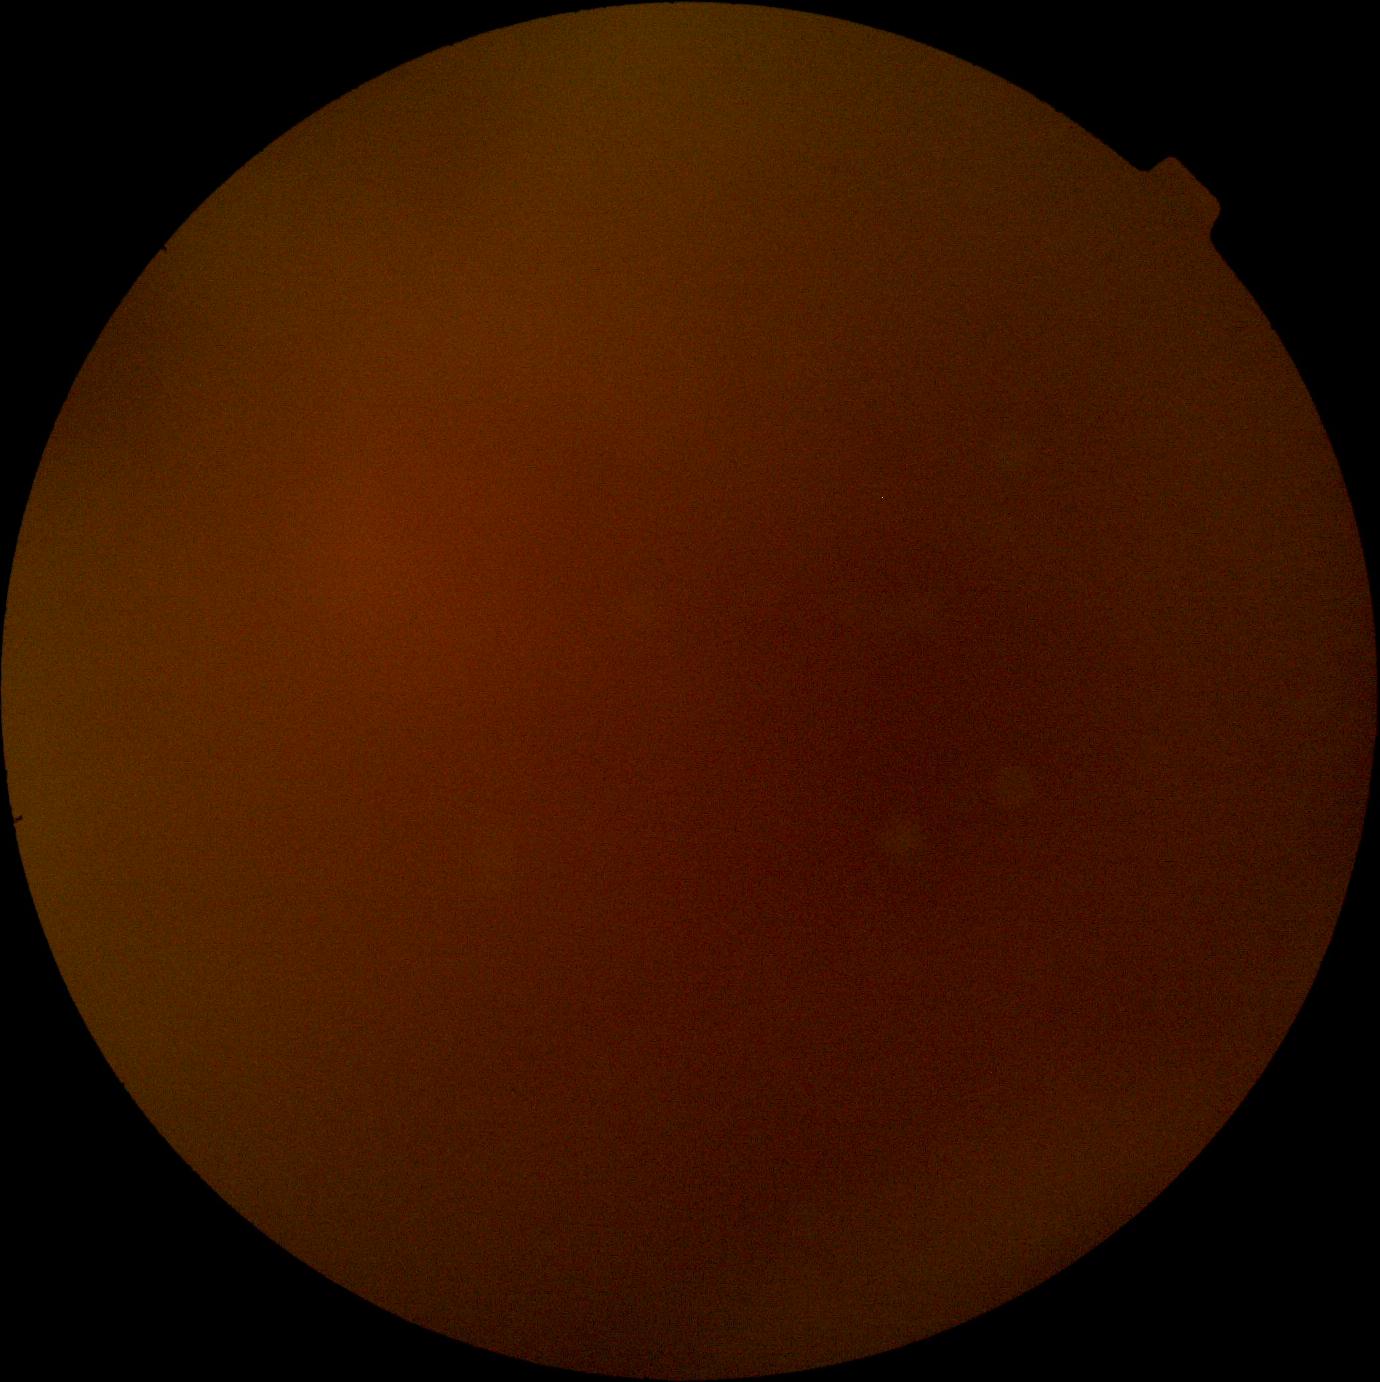

Diabetic retinopathy (DR): ungradable due to poor image quality.